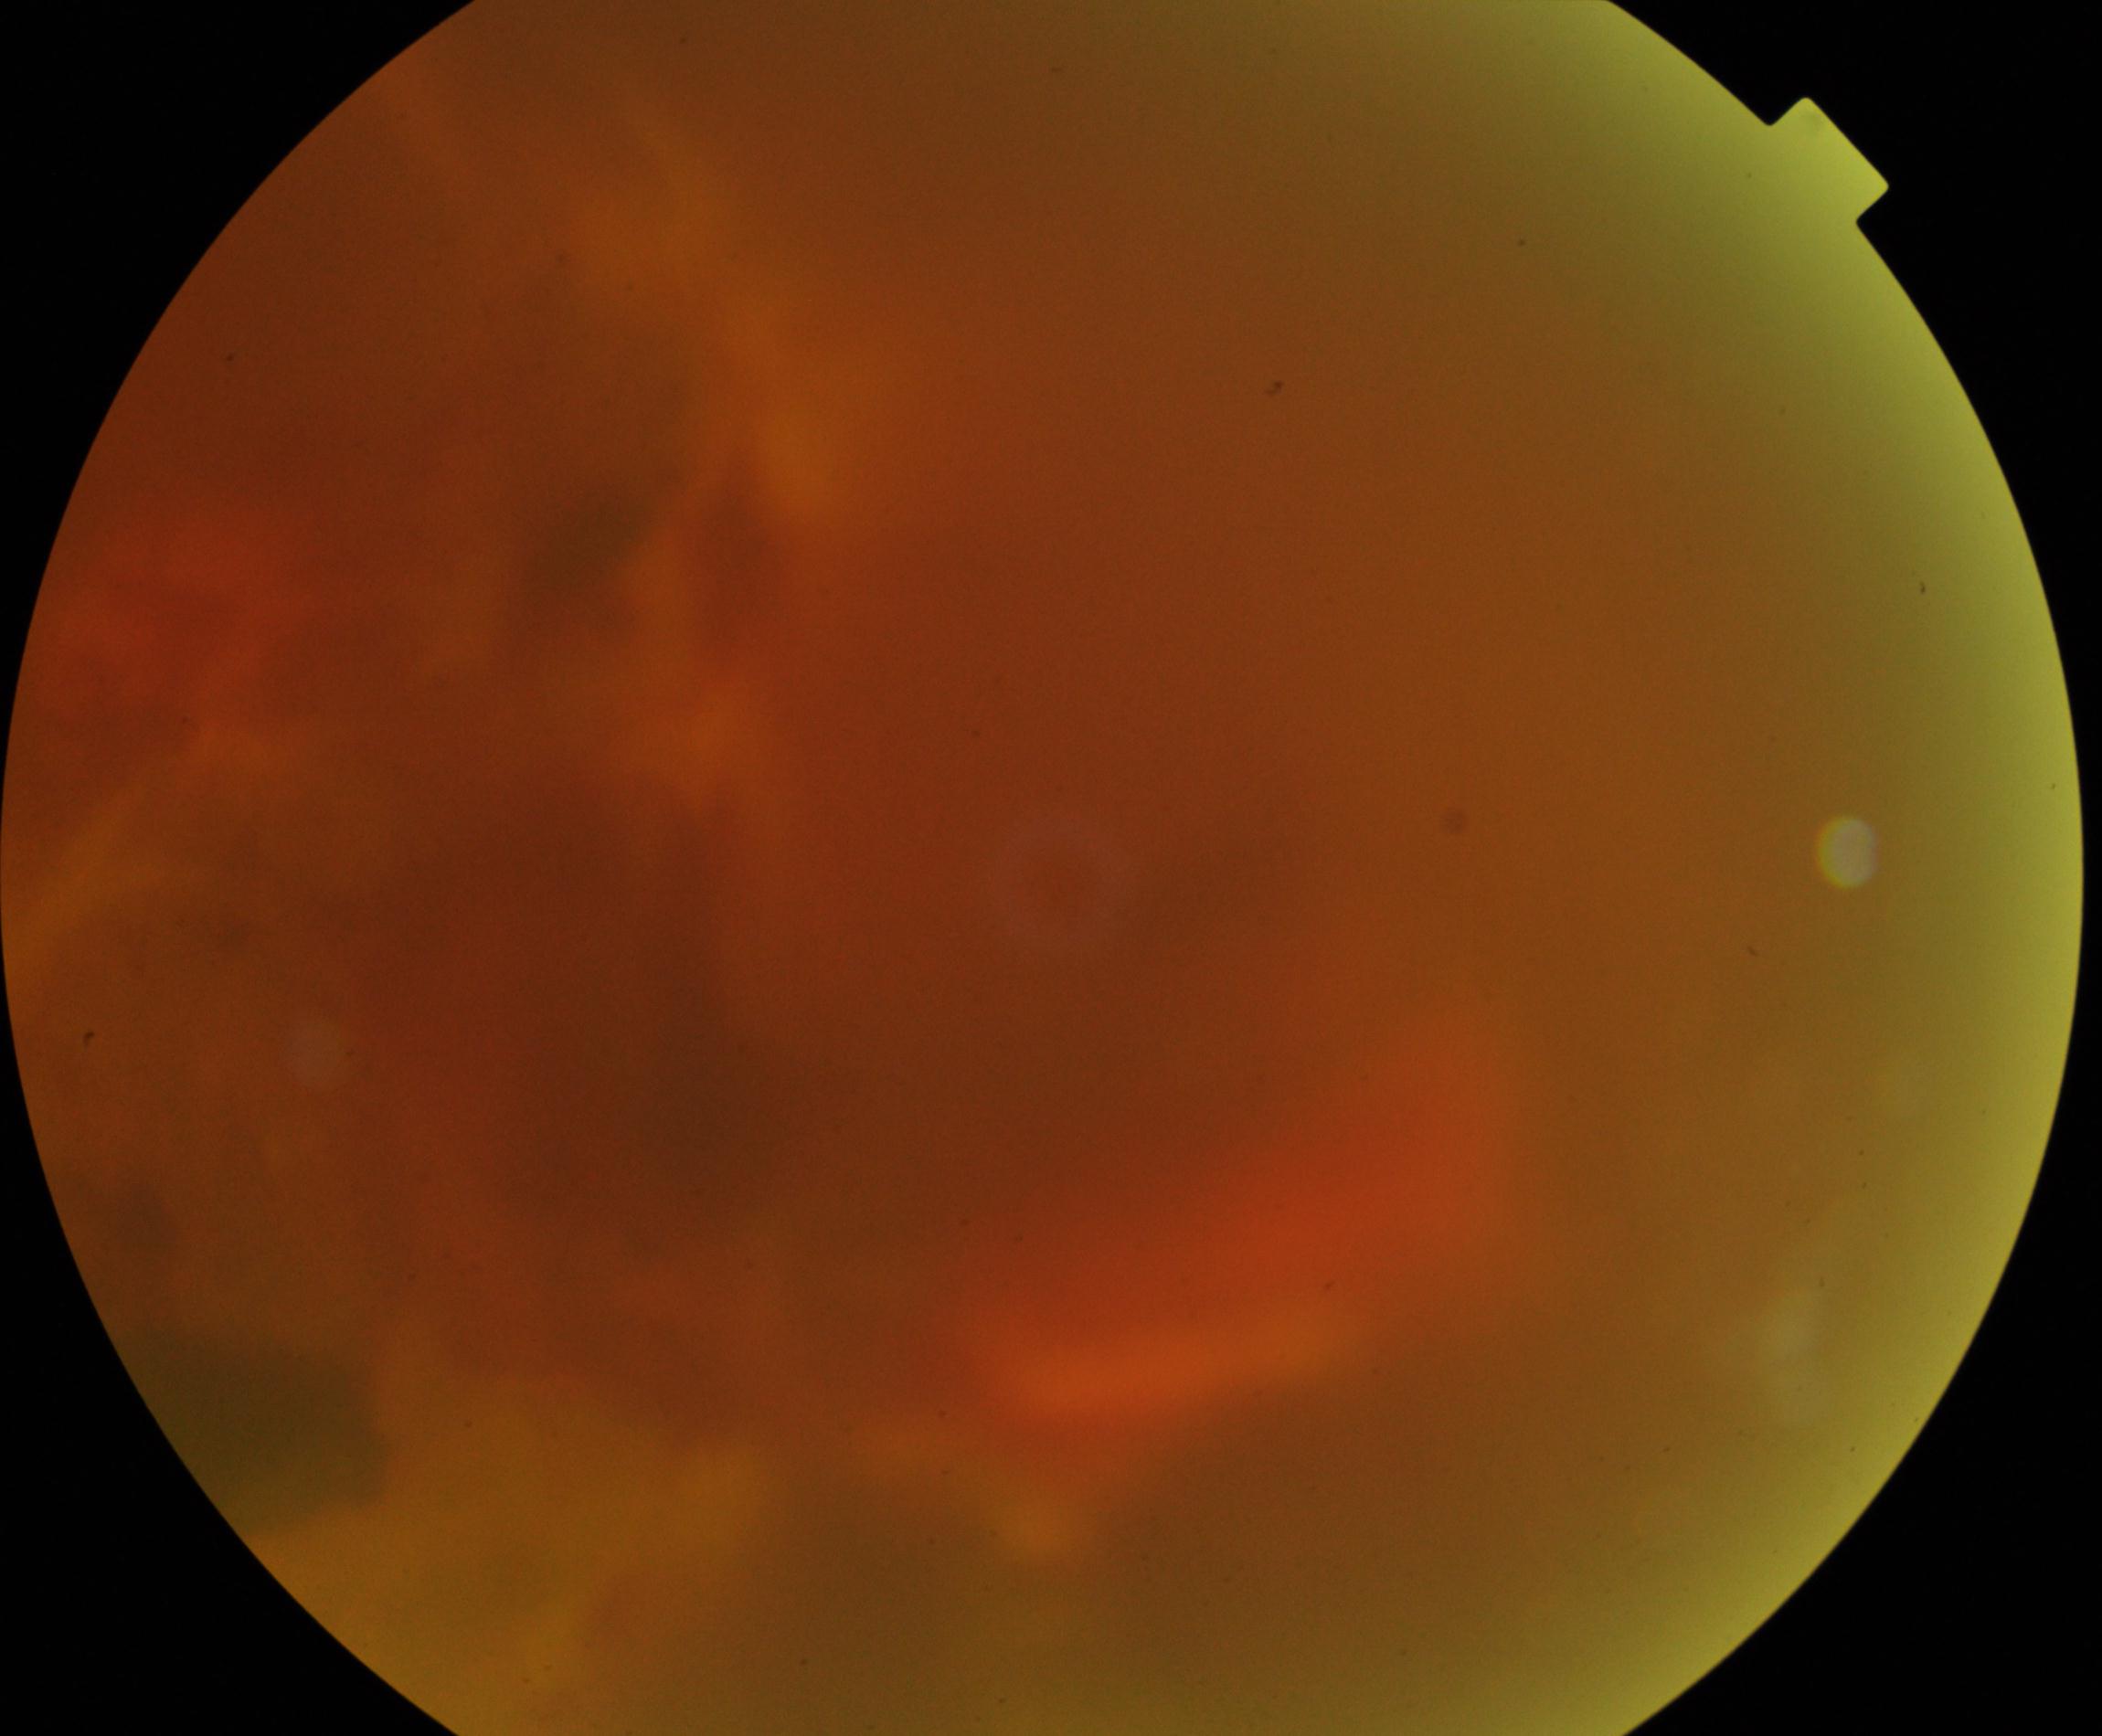 Poor-quality fundus photograph; retinal landmarks are largely obscured. Proliferative diabetic retinopathy is suspected.